Infant wide-field retinal image — 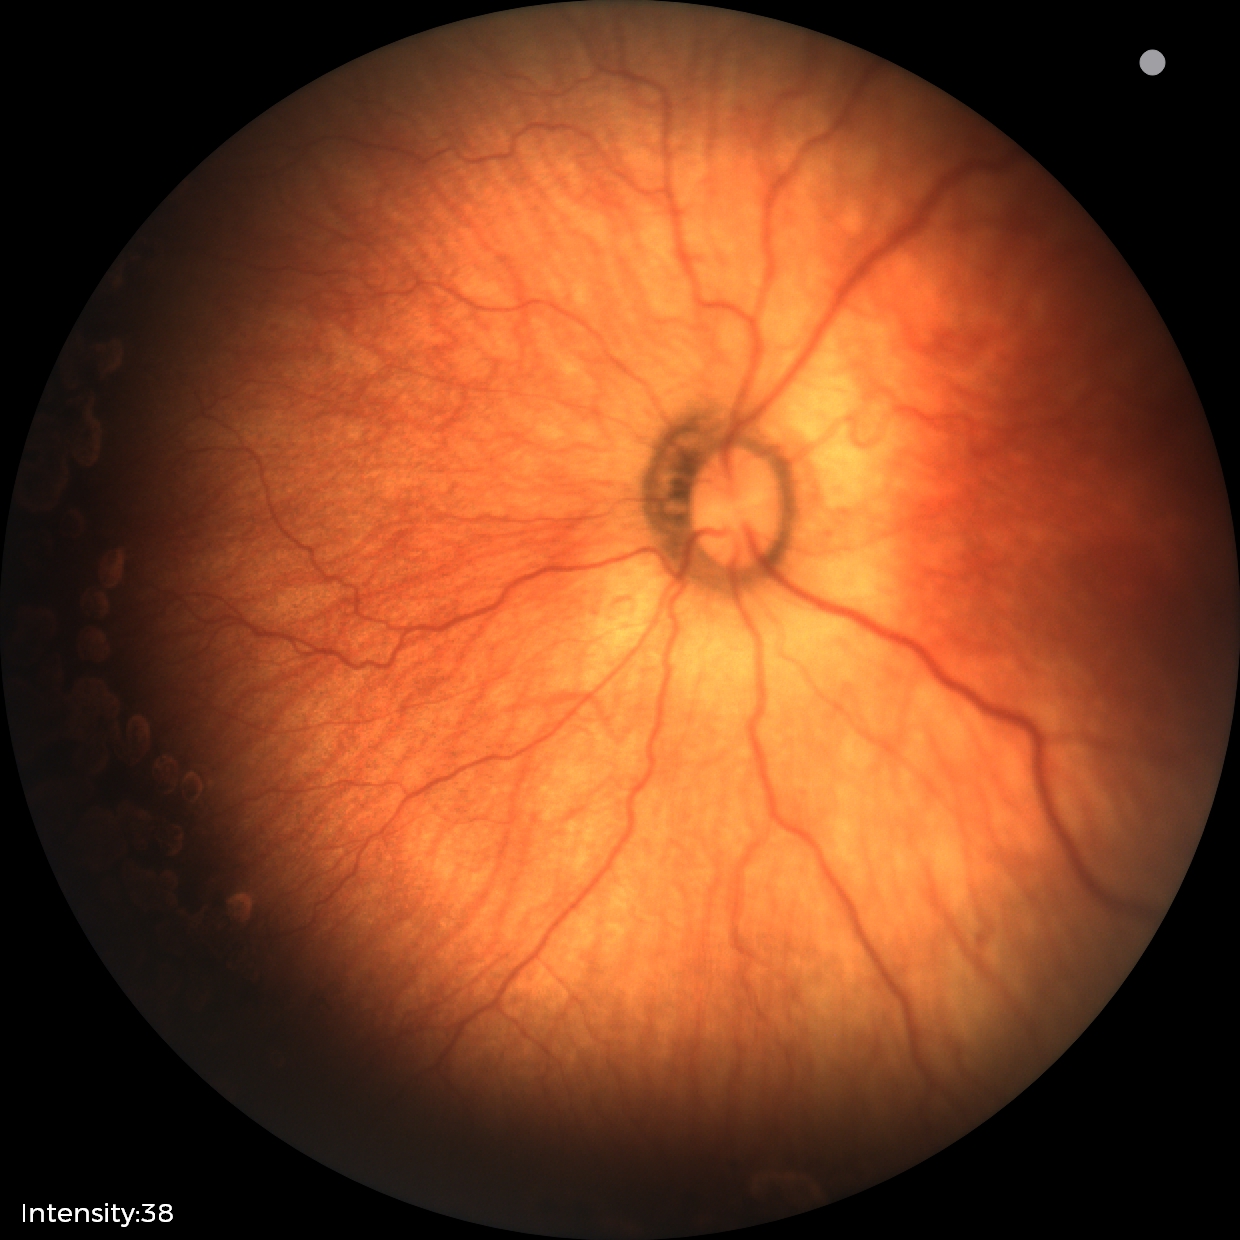

Impression: status post ROP; no plus disease — posterior pole vessels without abnormal dilation or tortuosity.